Wide-field fundus image from infant ROP screening — 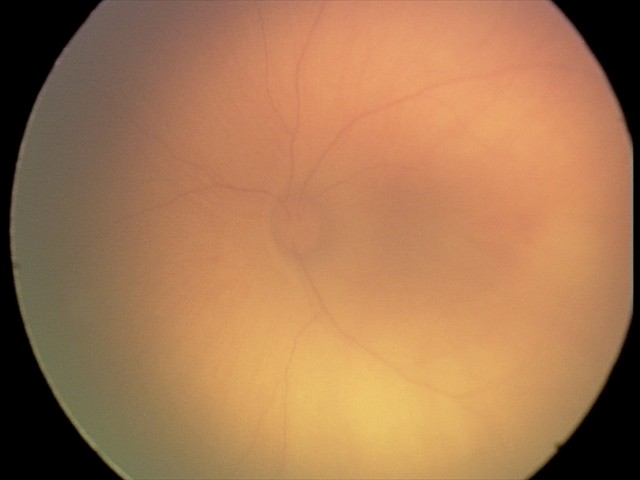
Screening series with retinal hemorrhages.